Diabetic retinopathy graded by the modified Davis classification — 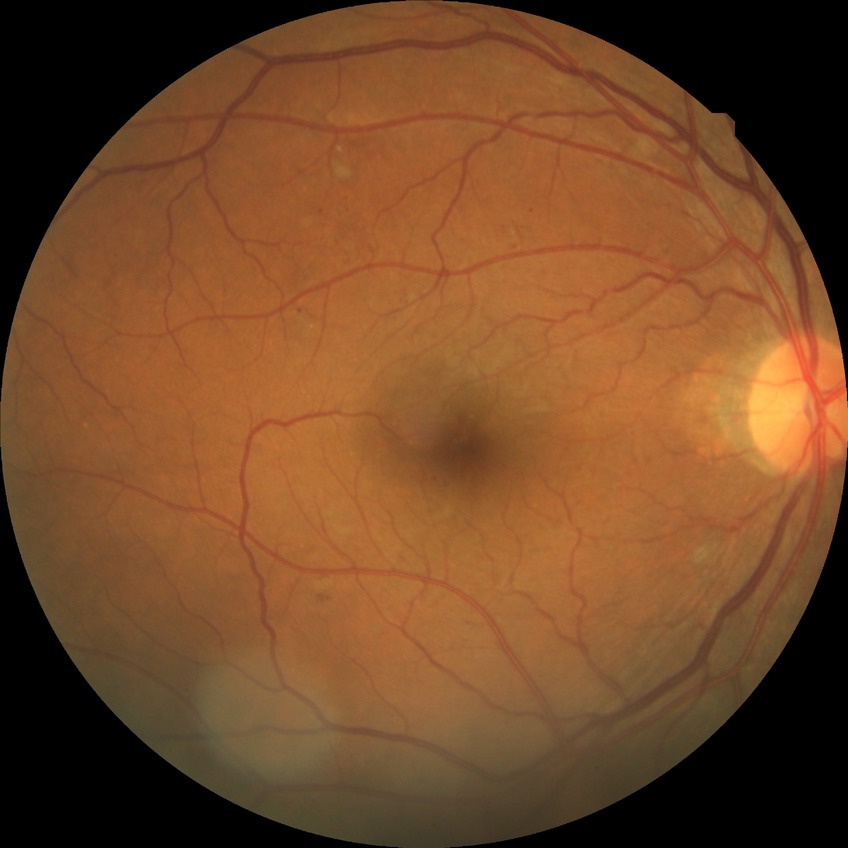
Modified Davis classification is pre-proliferative diabetic retinopathy.